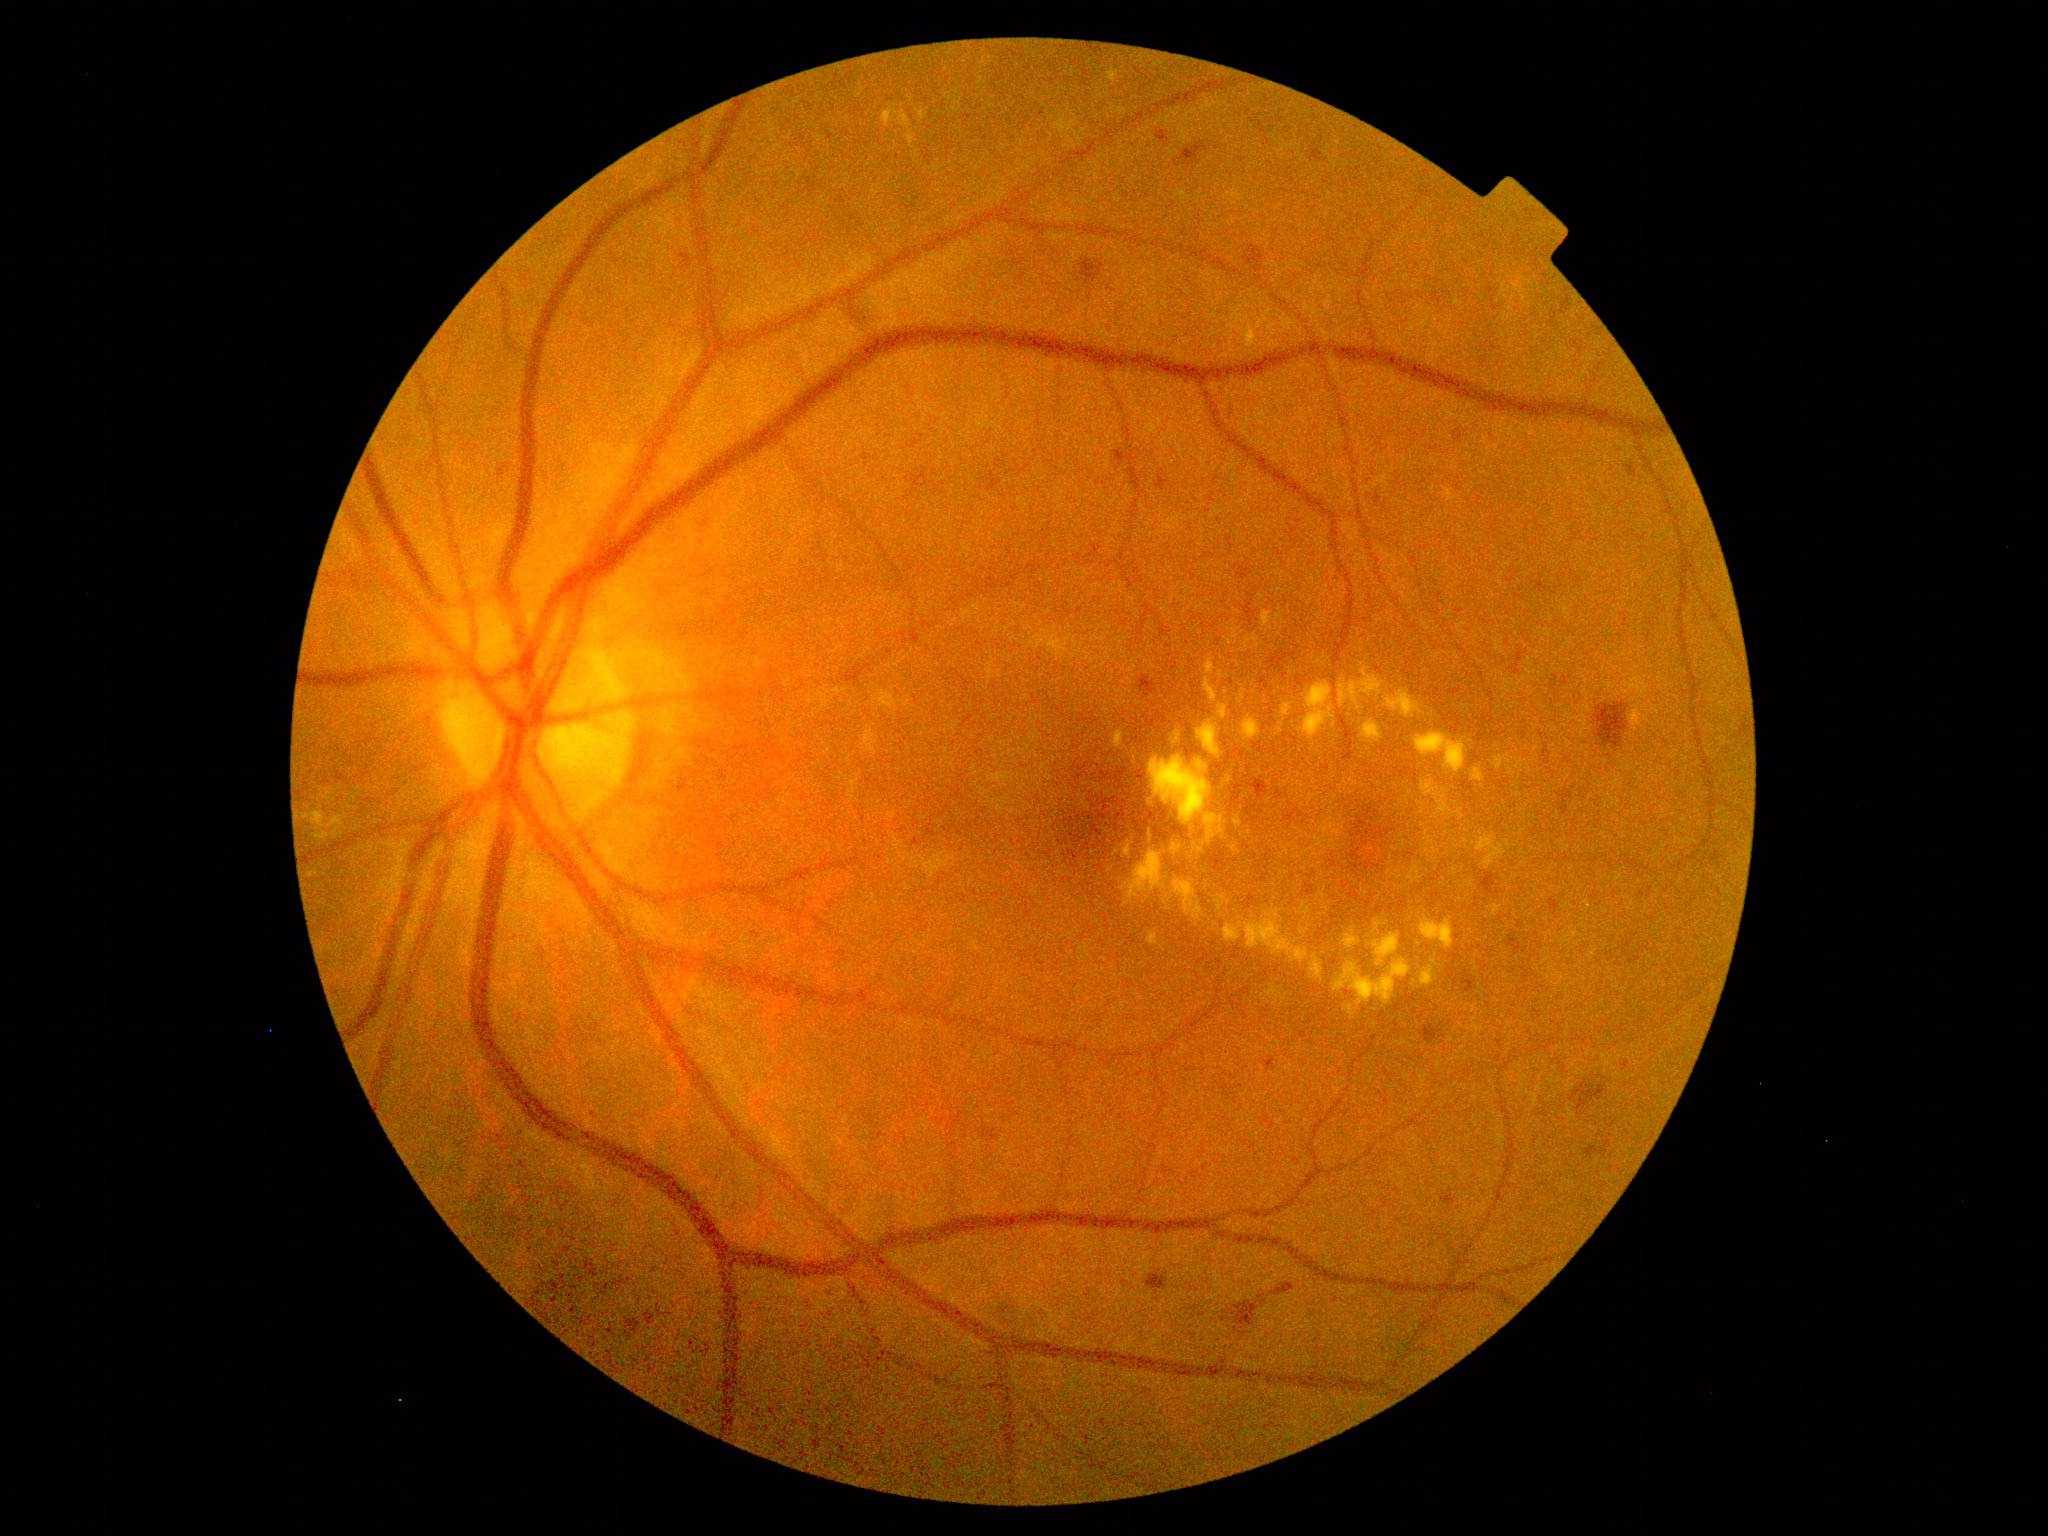
Retinopathy: moderate NPDR (grade 2)
Lesions identified (partial list):
hemorrhages (subset) = [551, 1282, 560, 1293] | [1235, 1302, 1258, 1326] | [1072, 851, 1079, 861] | [1463, 969, 1477, 994] | [1133, 803, 1148, 818] | [1089, 796, 1129, 838] | [983, 1129, 999, 1141] | [1420, 1025, 1440, 1044] | [1085, 841, 1090, 851] | [983, 472, 1004, 493] | [1148, 1274, 1168, 1290] | [1310, 149, 1328, 163] | [335, 769, 347, 782] | [906, 467, 940, 497] | [1628, 465, 1638, 478]
Additional small hemorrhages near (1410; 855) | (1123; 840) | (1139; 843) | (1643; 894)
microaneurysms = [588, 1110, 593, 1118]
Additional small microaneurysms near (512; 1168) | (523; 1166)
soft exudates = absent
hard exudates (subset) = [1343, 926, 1361, 951] | [1629, 703, 1651, 733] | [1149, 756, 1225, 855] | [1503, 679, 1514, 694] | [1516, 760, 1522, 772] | [1281, 703, 1294, 722] | [1400, 840, 1406, 848] | [302, 812, 344, 842] | [1234, 816, 1242, 828] | [1461, 706, 1470, 710]
Additional small hard exudates near (1515; 915) | (1253; 684) | (1112; 761) | (1390; 873) | (1498; 1000) | (1163; 949) | (1423; 825) | (1437; 837) | (1395; 850)